1240 by 1240 pixels. Phoenix ICON wide-field infant fundus image — 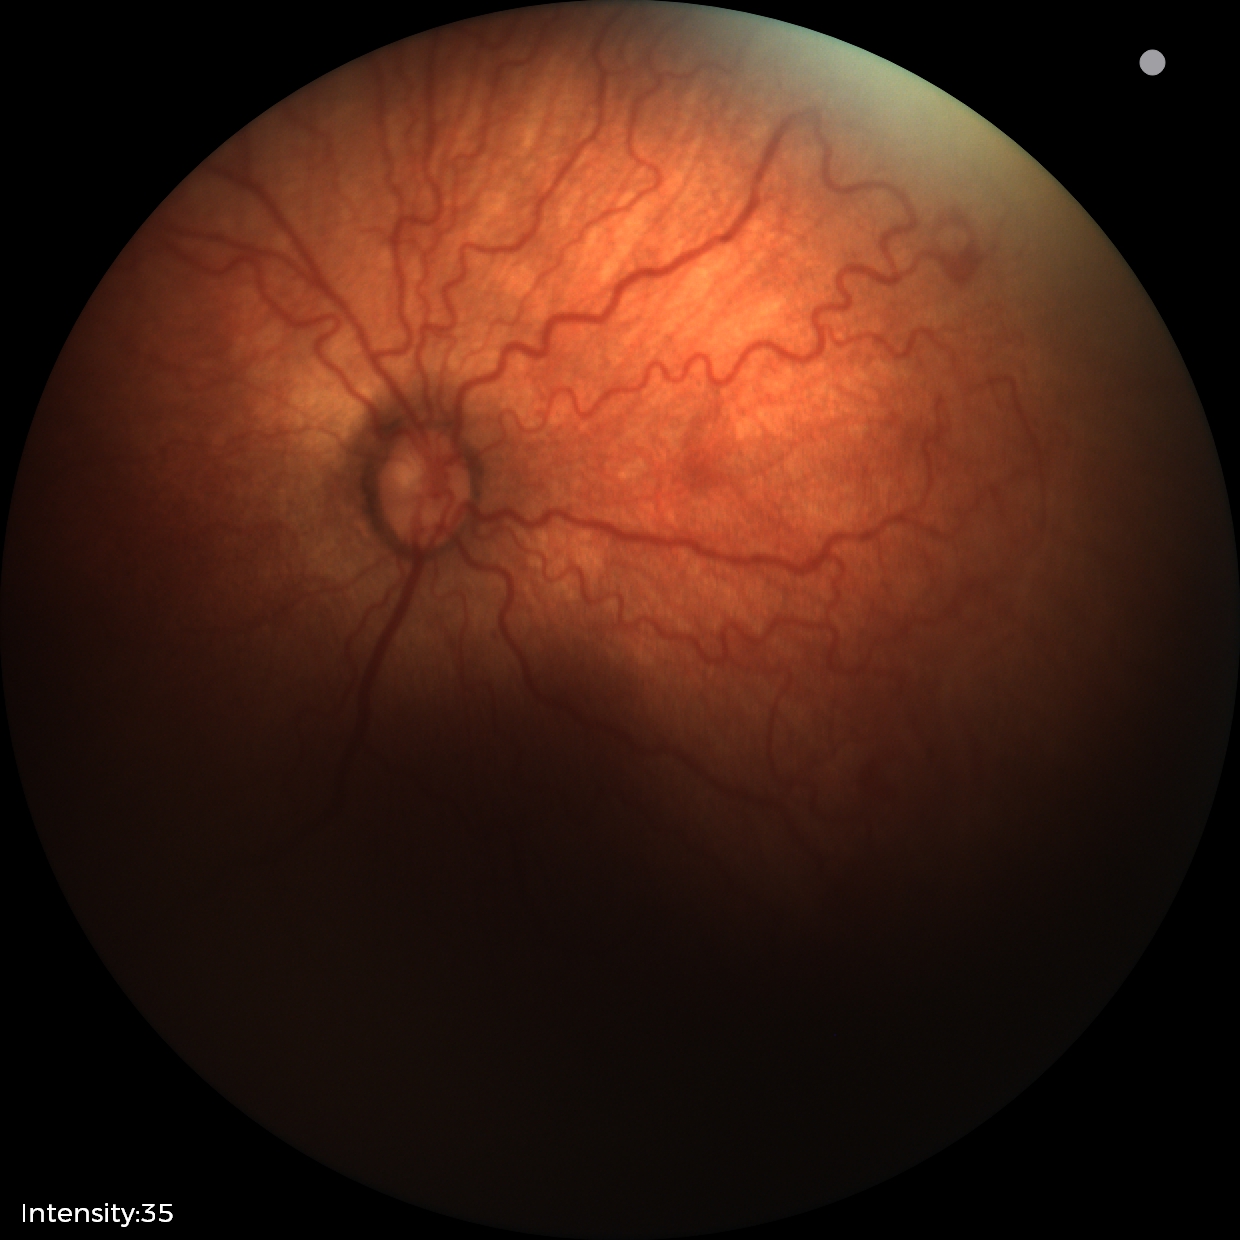
Assessment: ROP stage 2 | plus disease.